Retinal fundus photograph · 45° field of view:
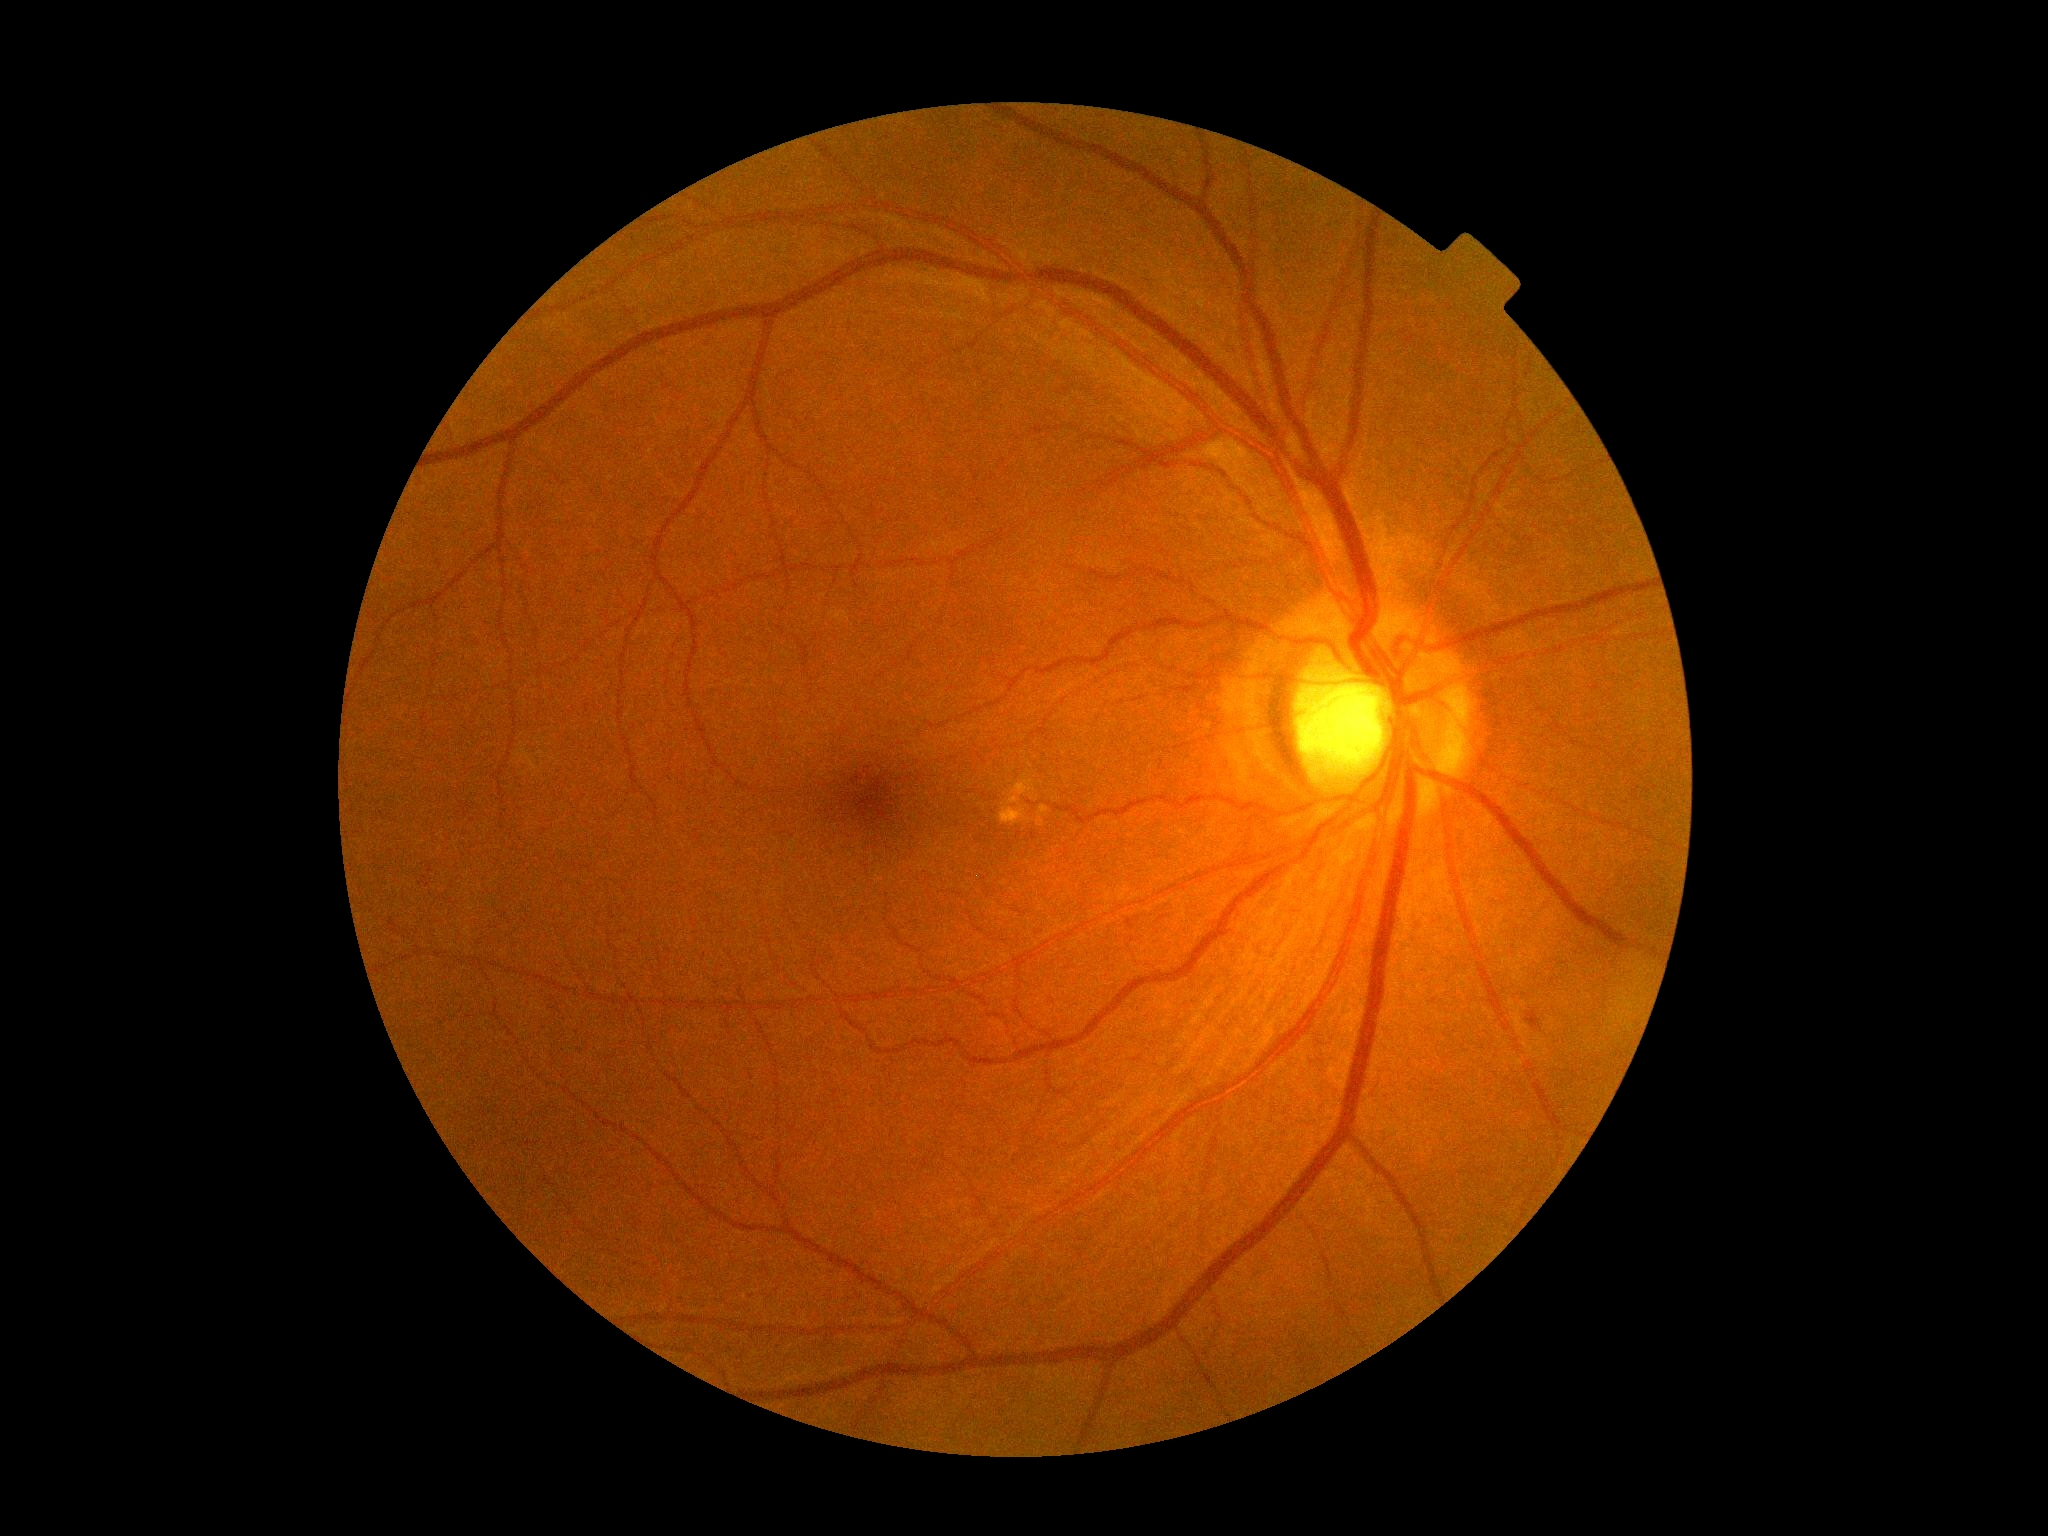
DR grade@2 (moderate NPDR), DR class@non-proliferative diabetic retinopathy.